1240 by 1240 pixels; Phoenix ICON wide-field infant fundus image: 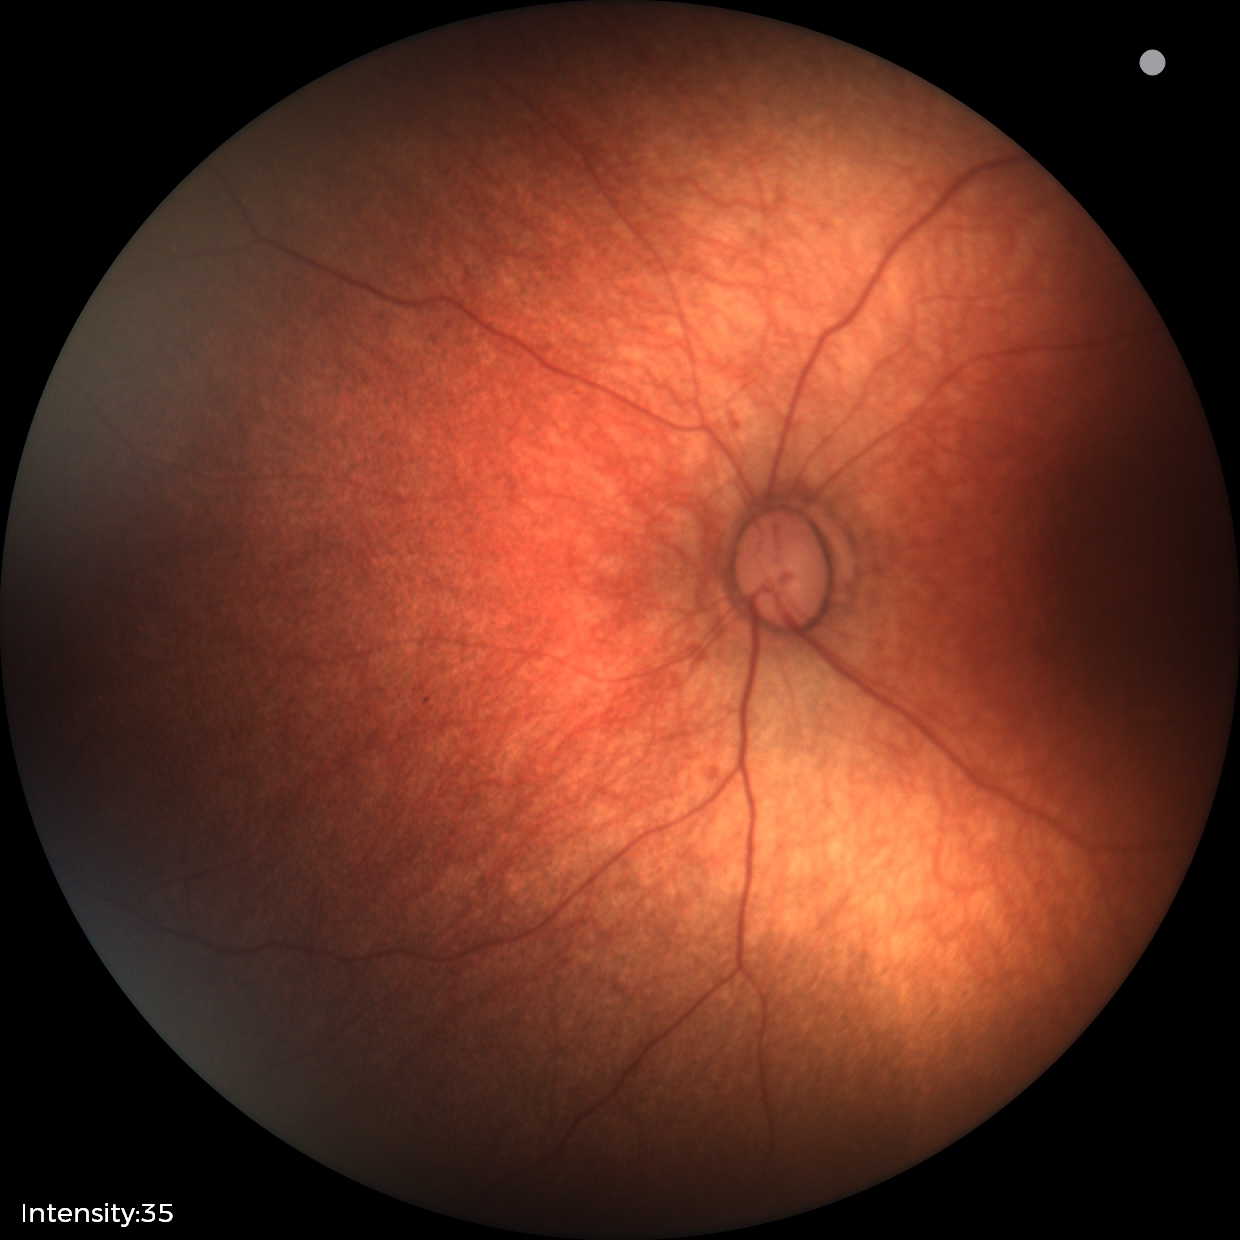

No retinal pathology identified on screening.